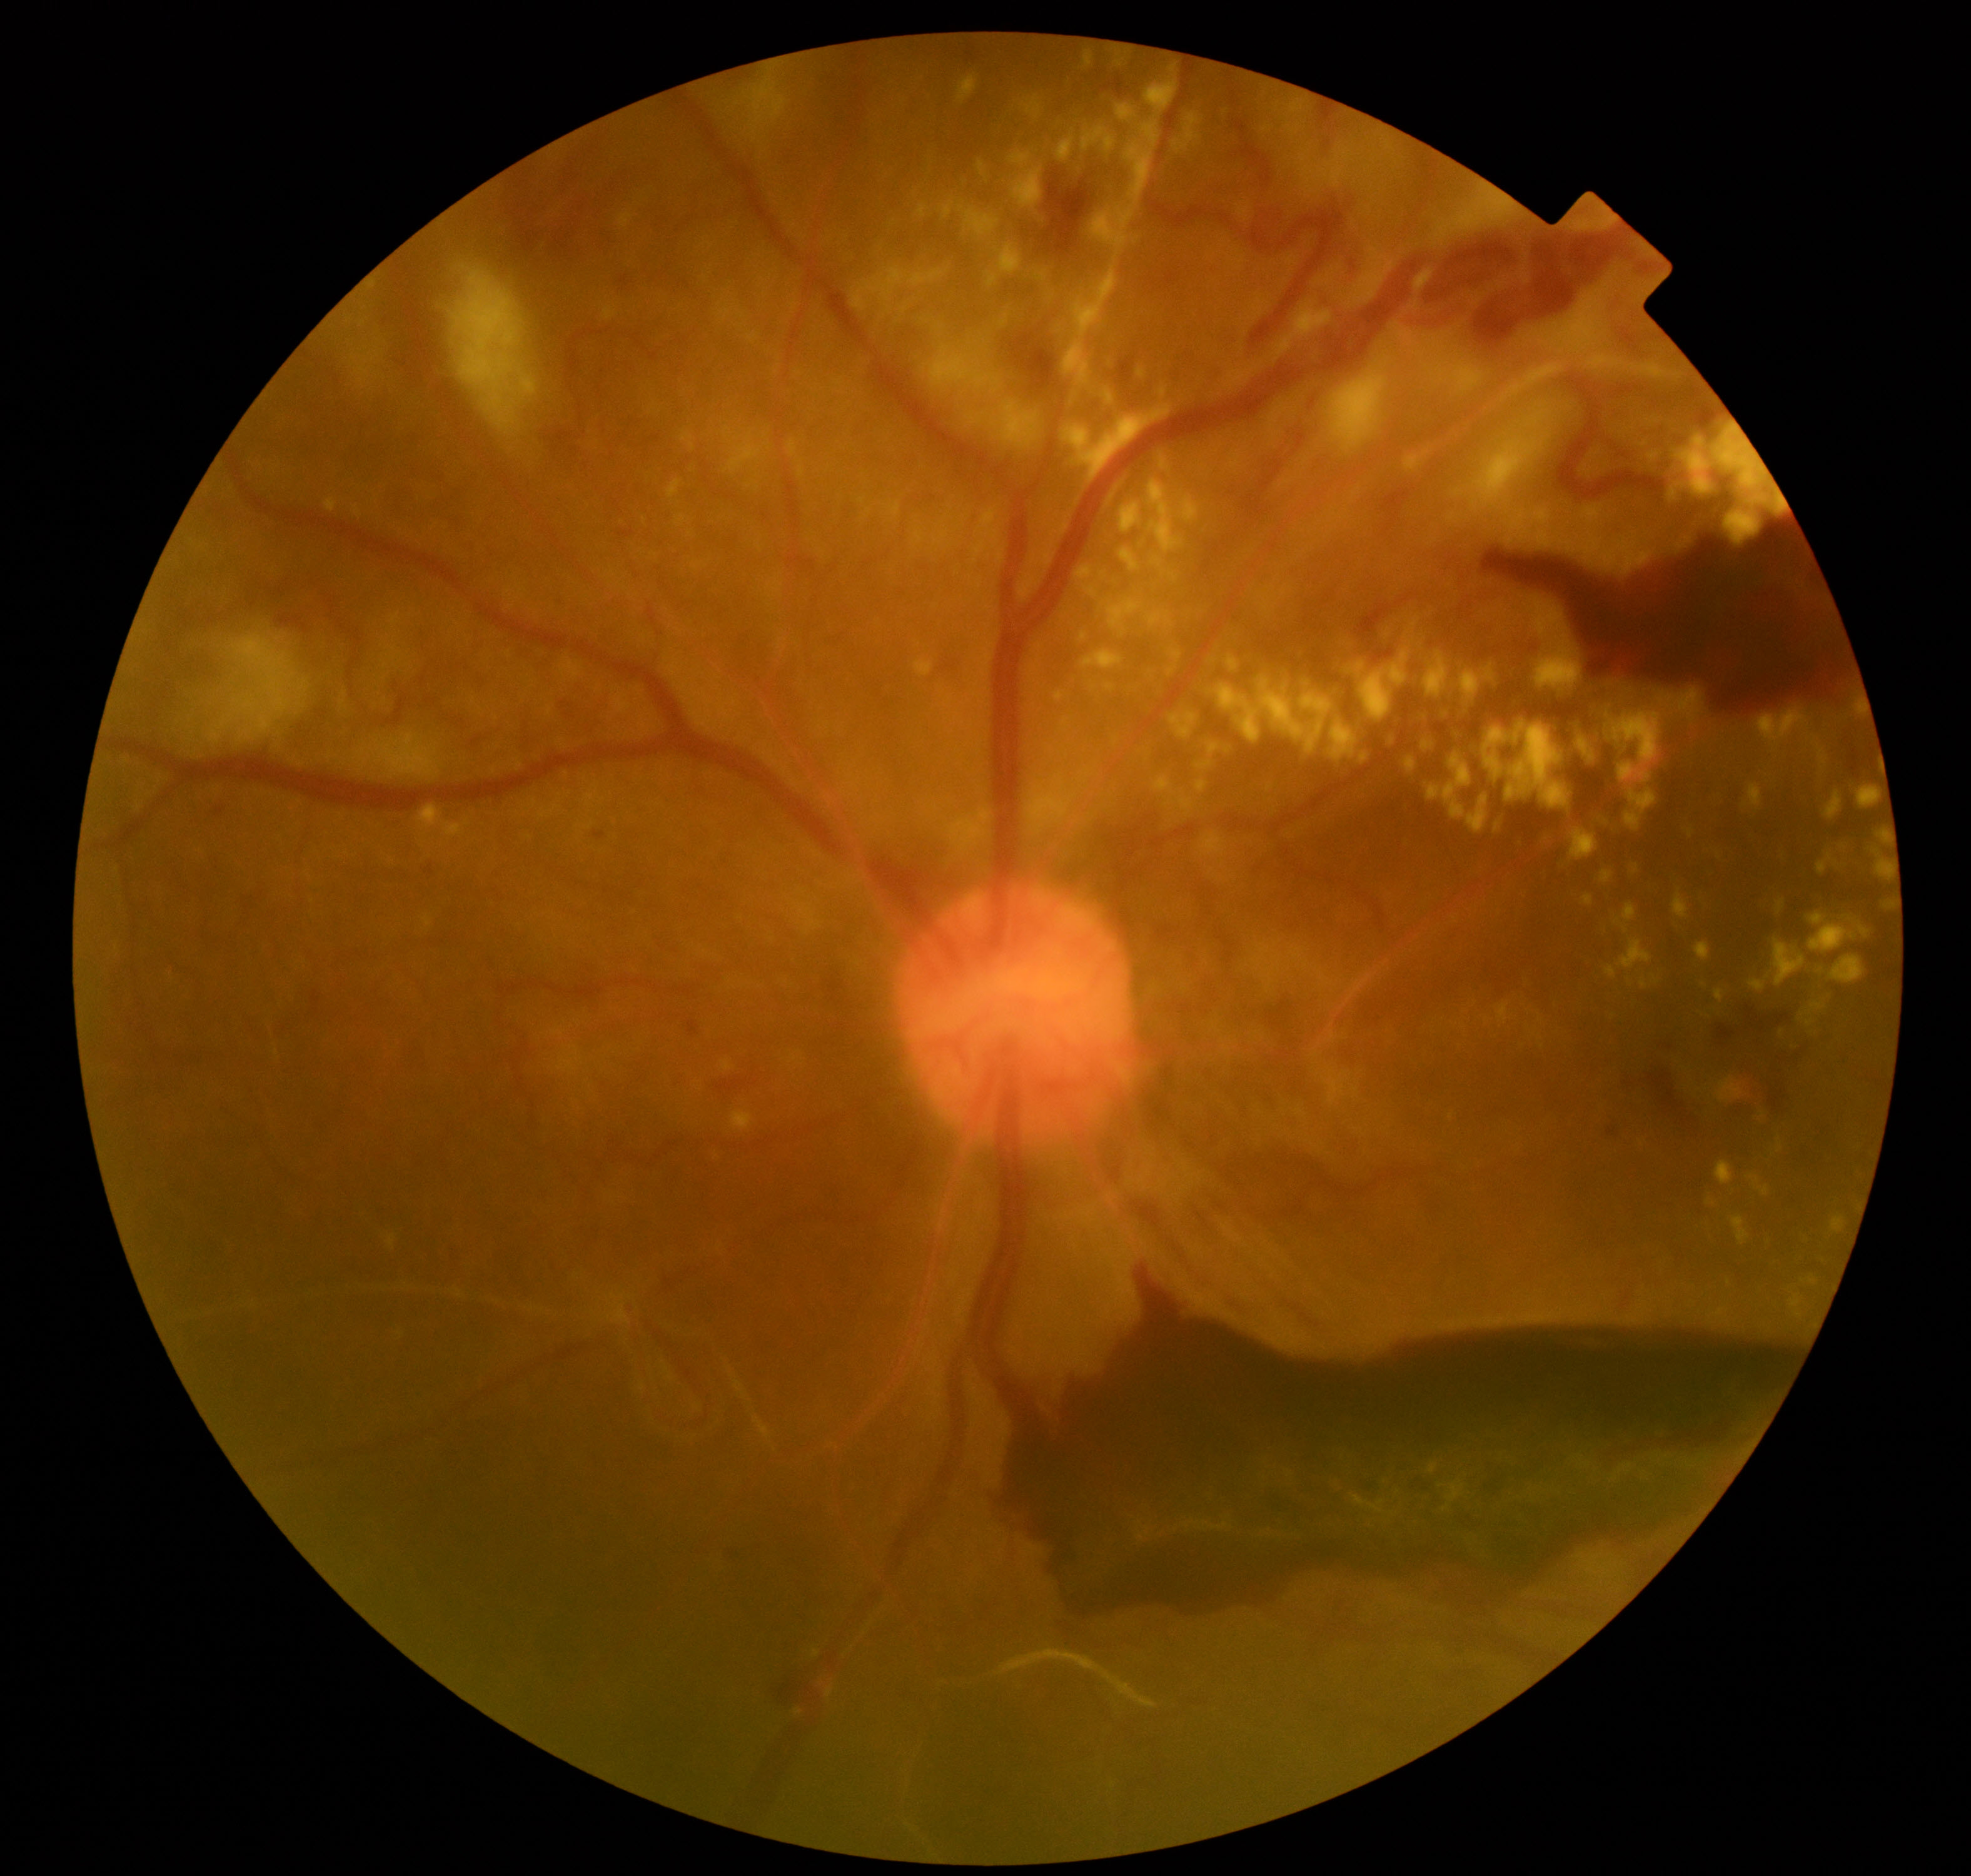

Diagnosis: severe non-proliferative or proliferative diabetic retinopathy.